Ultra-widefield fundus photograph; 200-degree field of view.
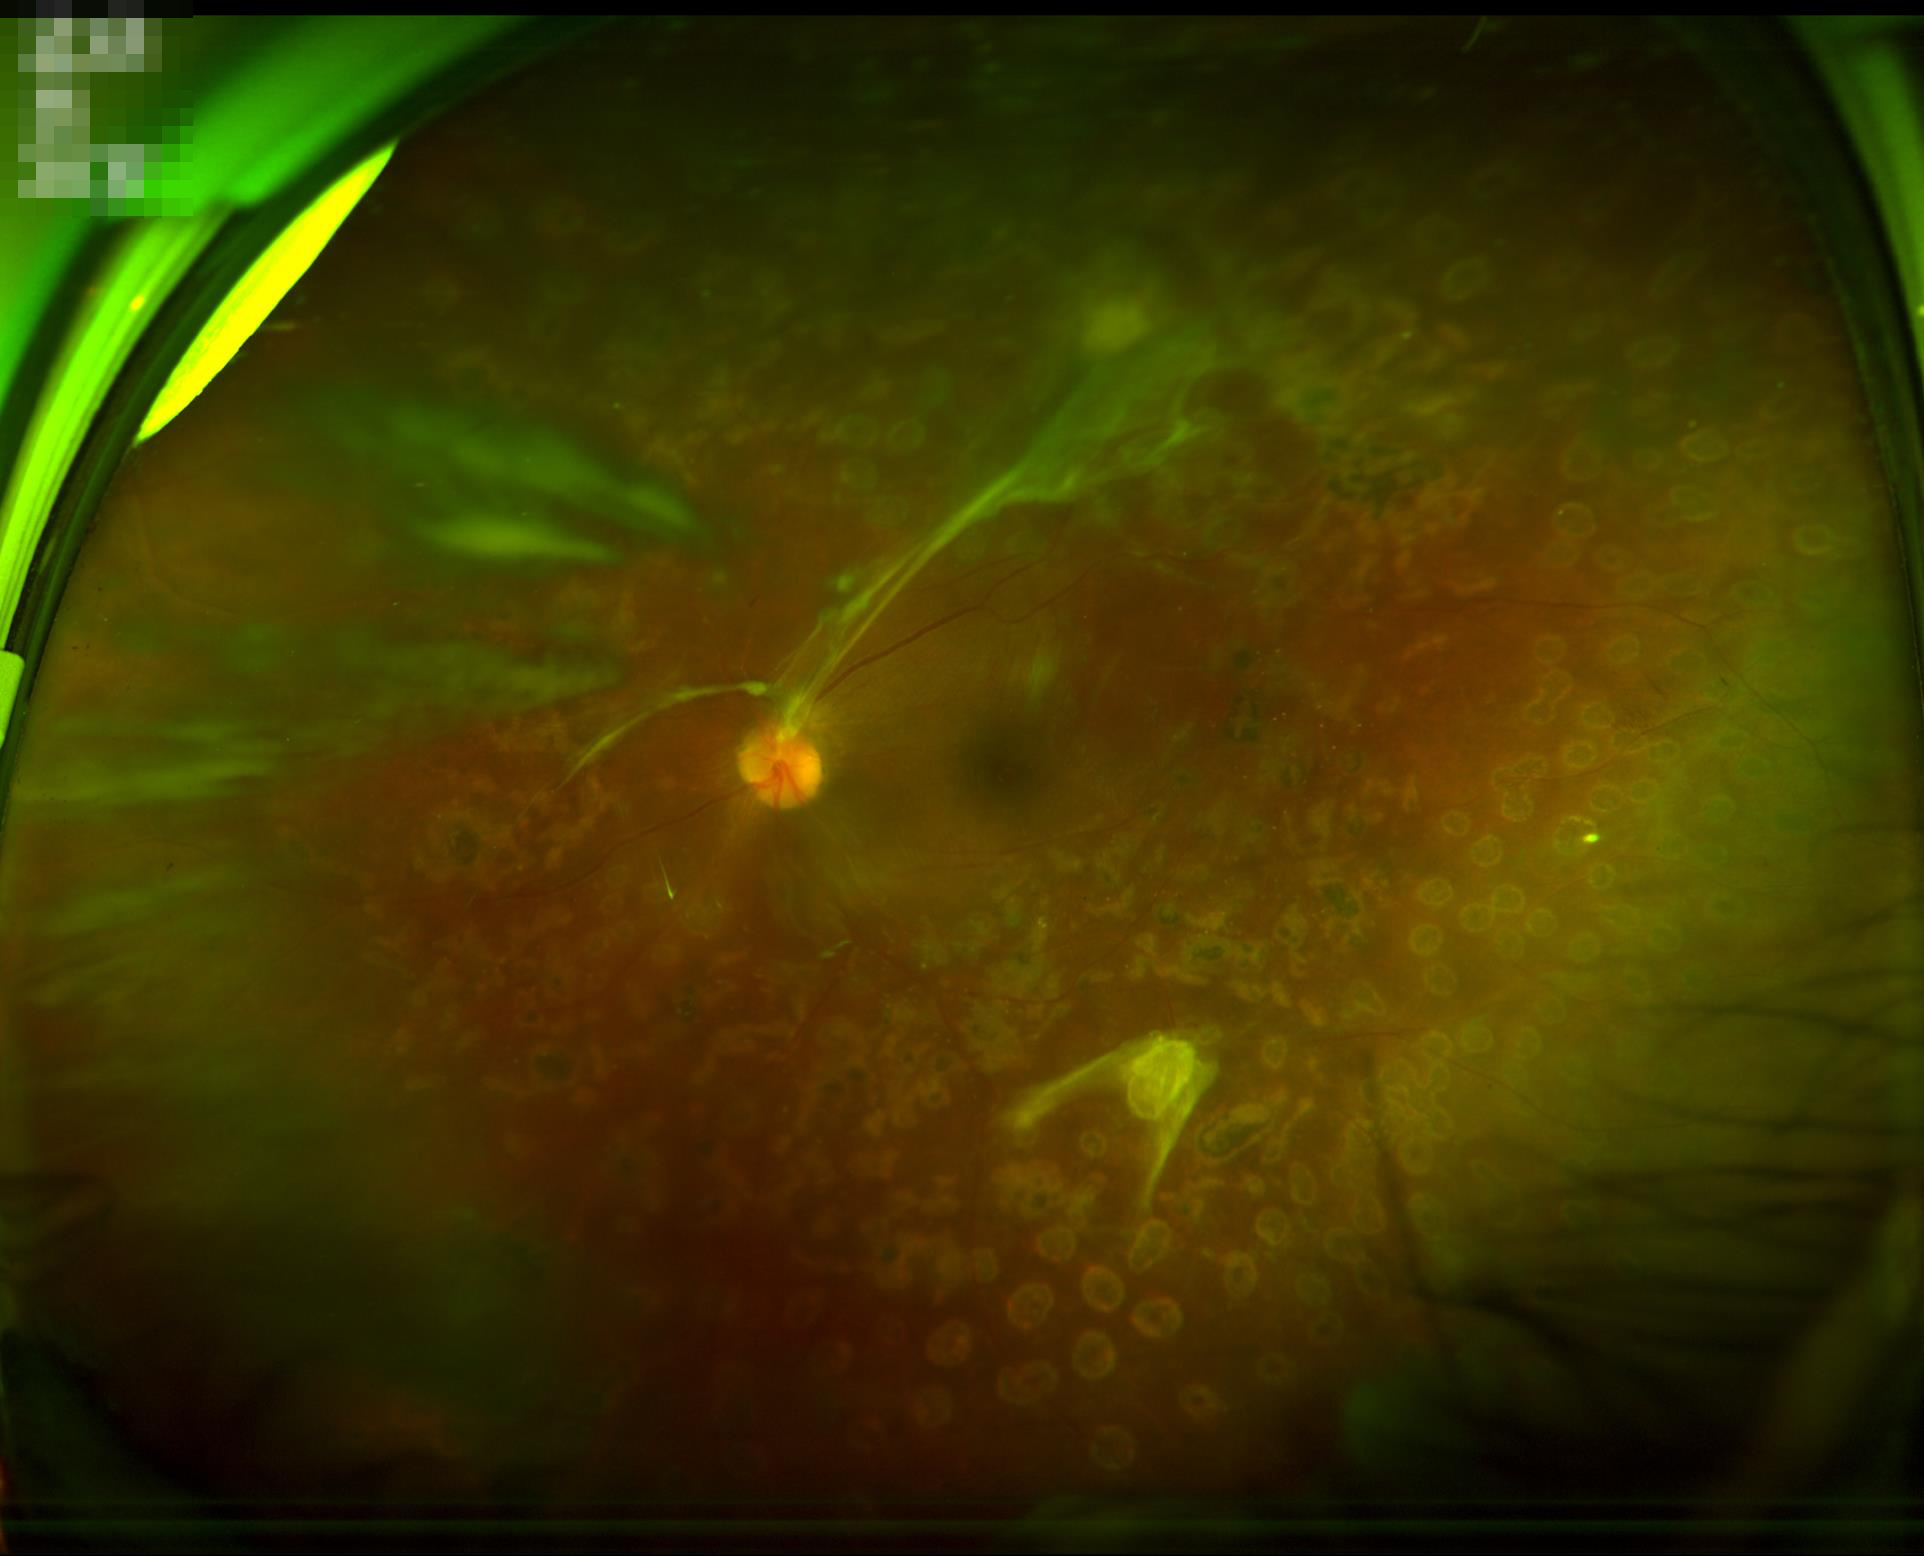 Illumination is uneven.
Contrast is good.
Noticeable blur in the optic disc, vessels, or background.
Image quality is suboptimal.